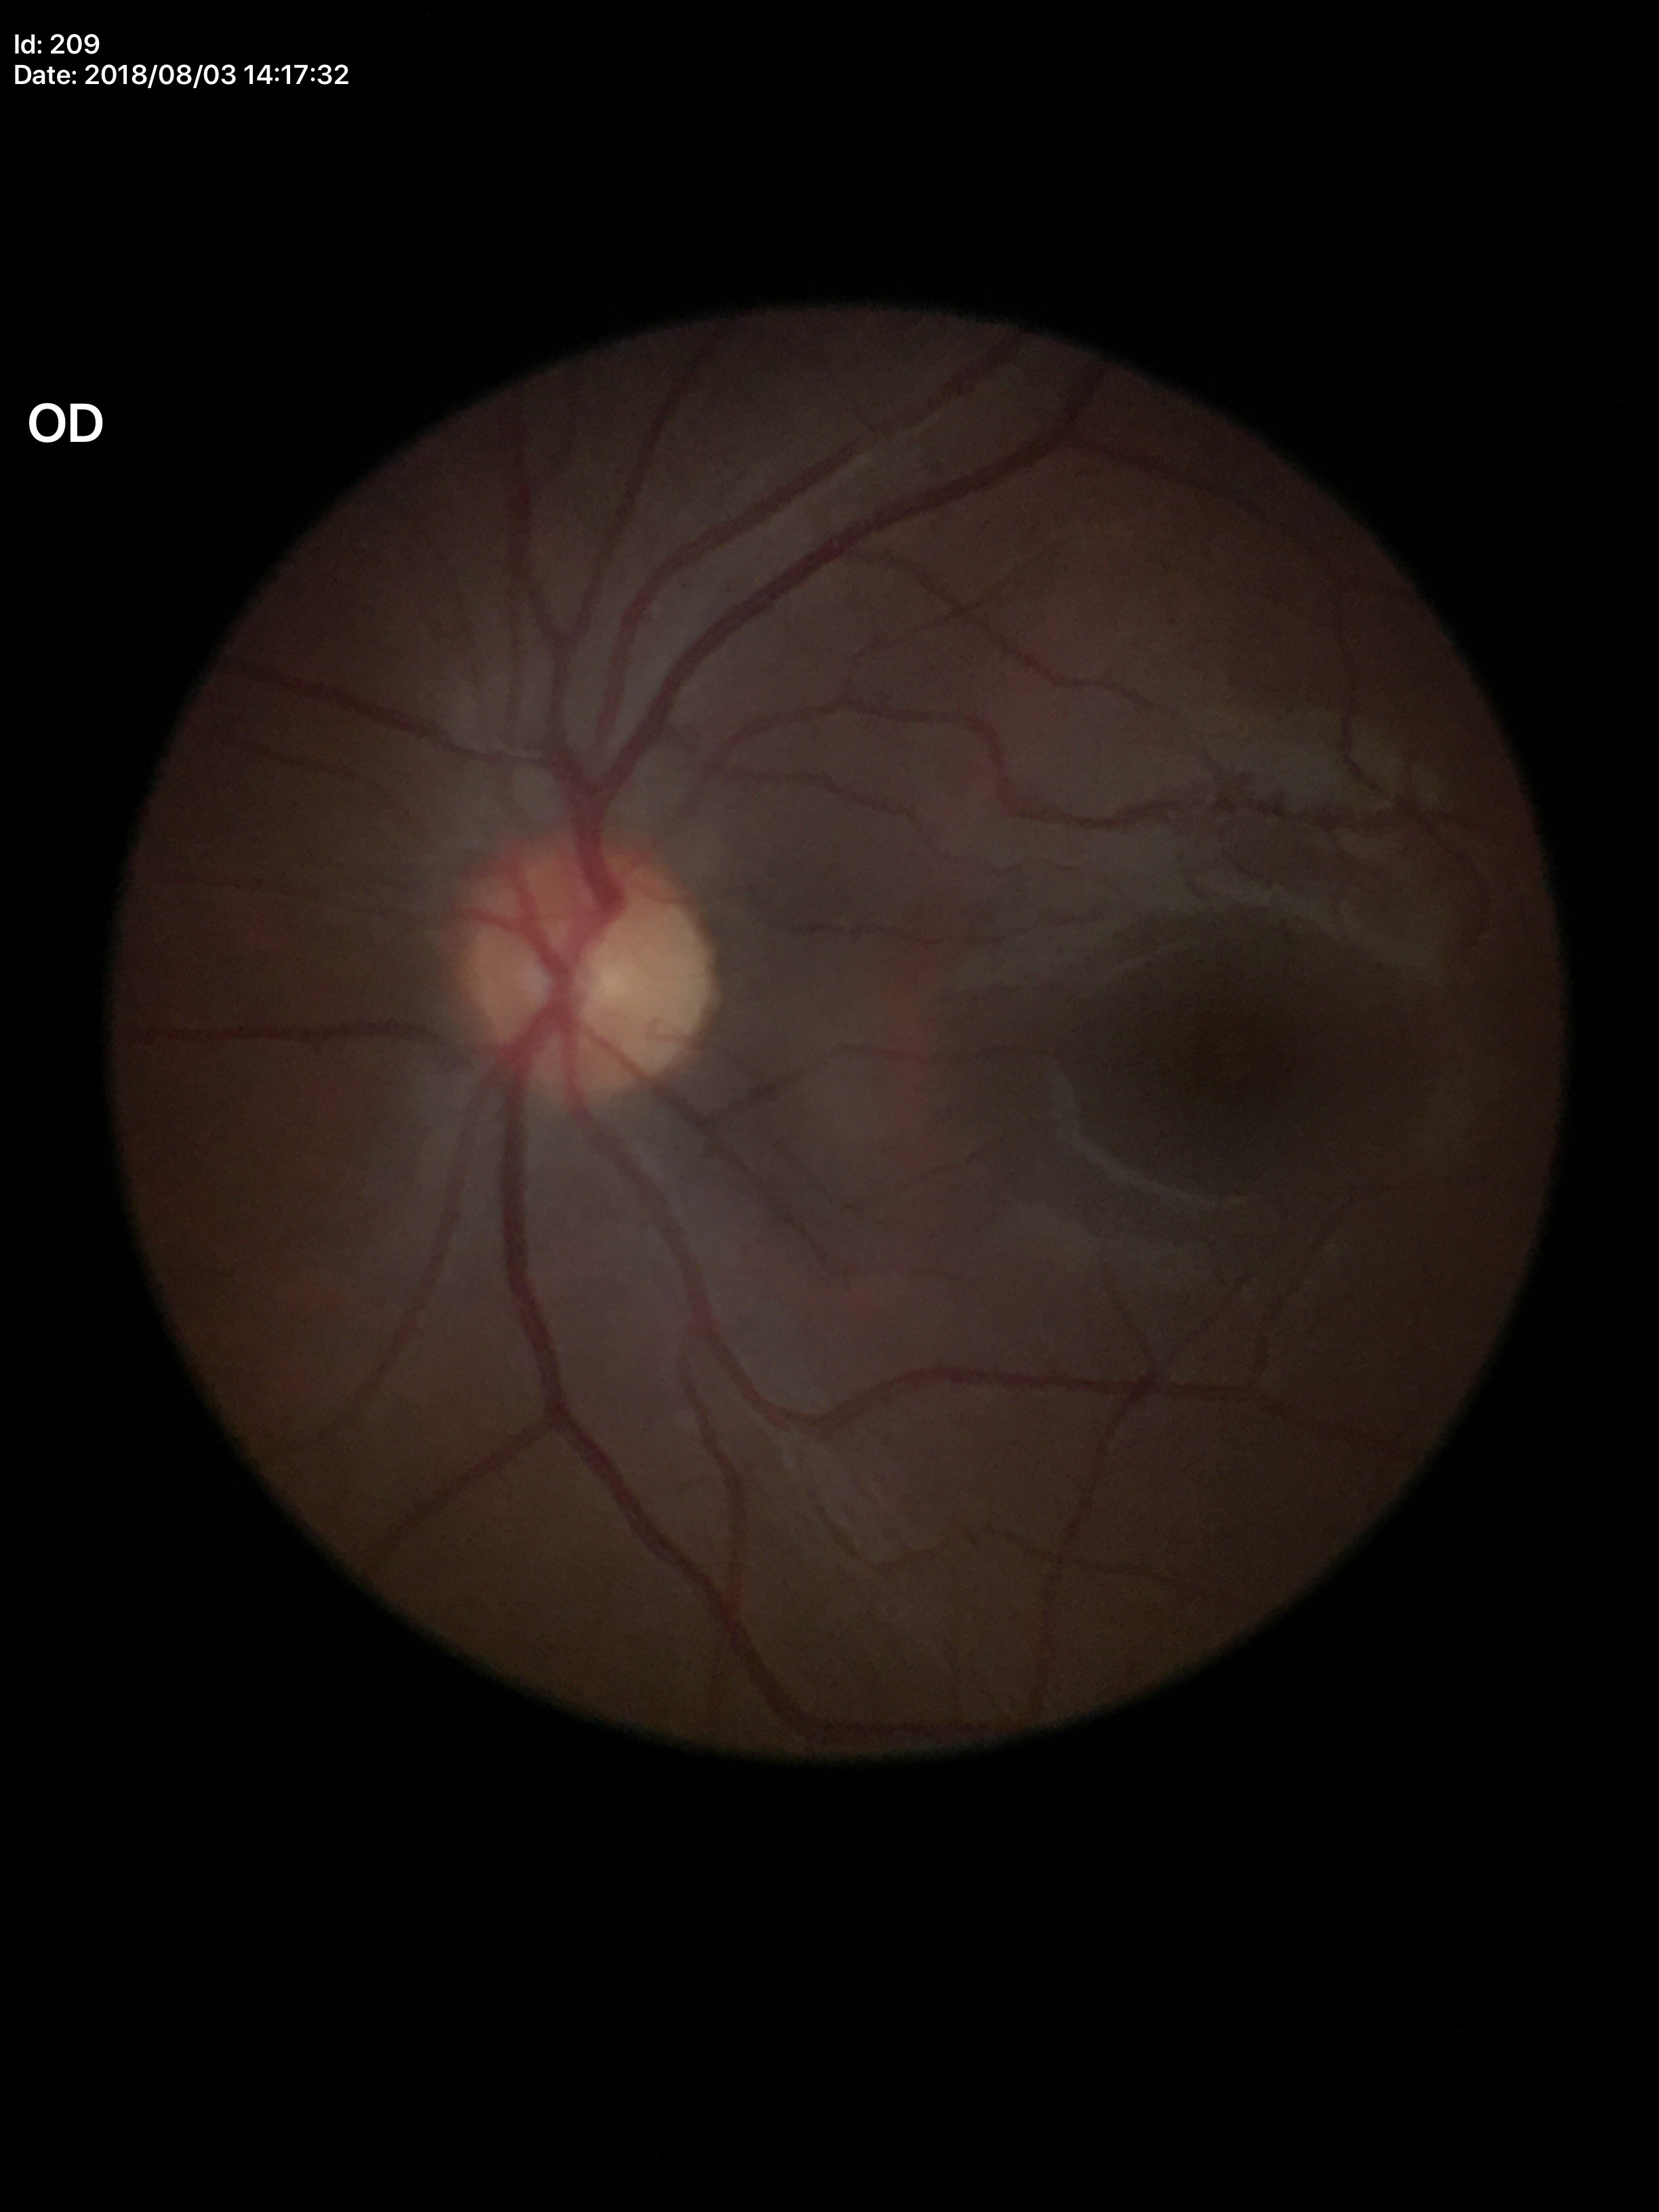
Annotations:
* vertical C/D ratio (VCDR) — 0.40
* horizontal CDR (HCDR) — 0.44
* area C/D ratio (ACDR) — 0.17
* Glaucoma screening impression — negative